Wide-field fundus image from infant ROP screening. Image size 640x480.
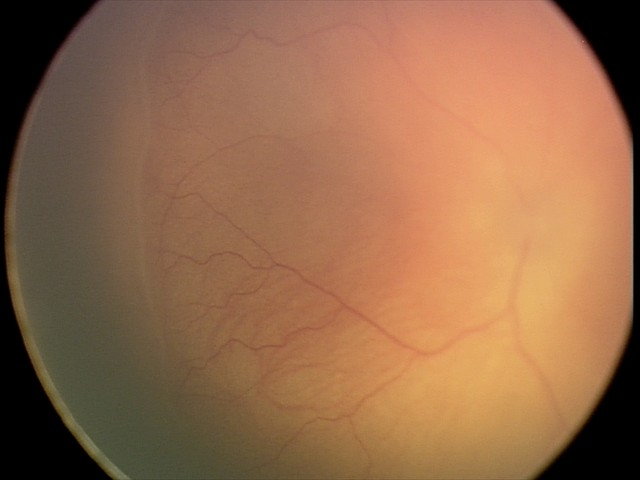 Impression: retinopathy of prematurity stage 2.